45 degree fundus photograph · 848x848px:
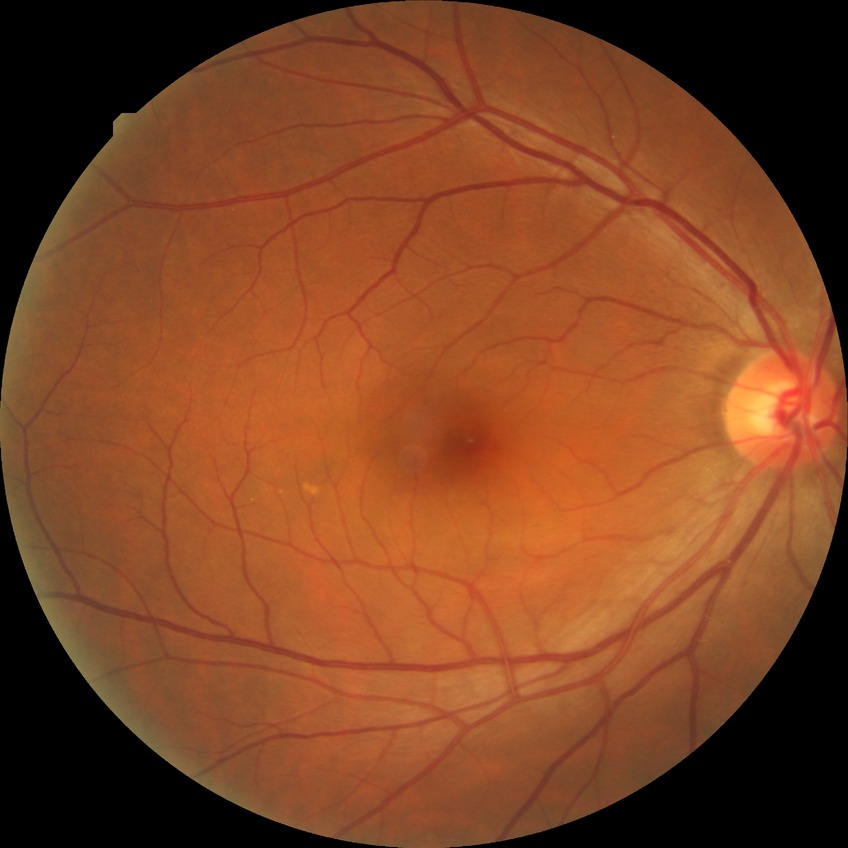
– DR impression: no signs of DR
– Davis grade: NDR